Fundus photo taken with a portable handheld camera. 60-degree field of view. Image size 2212x1659: 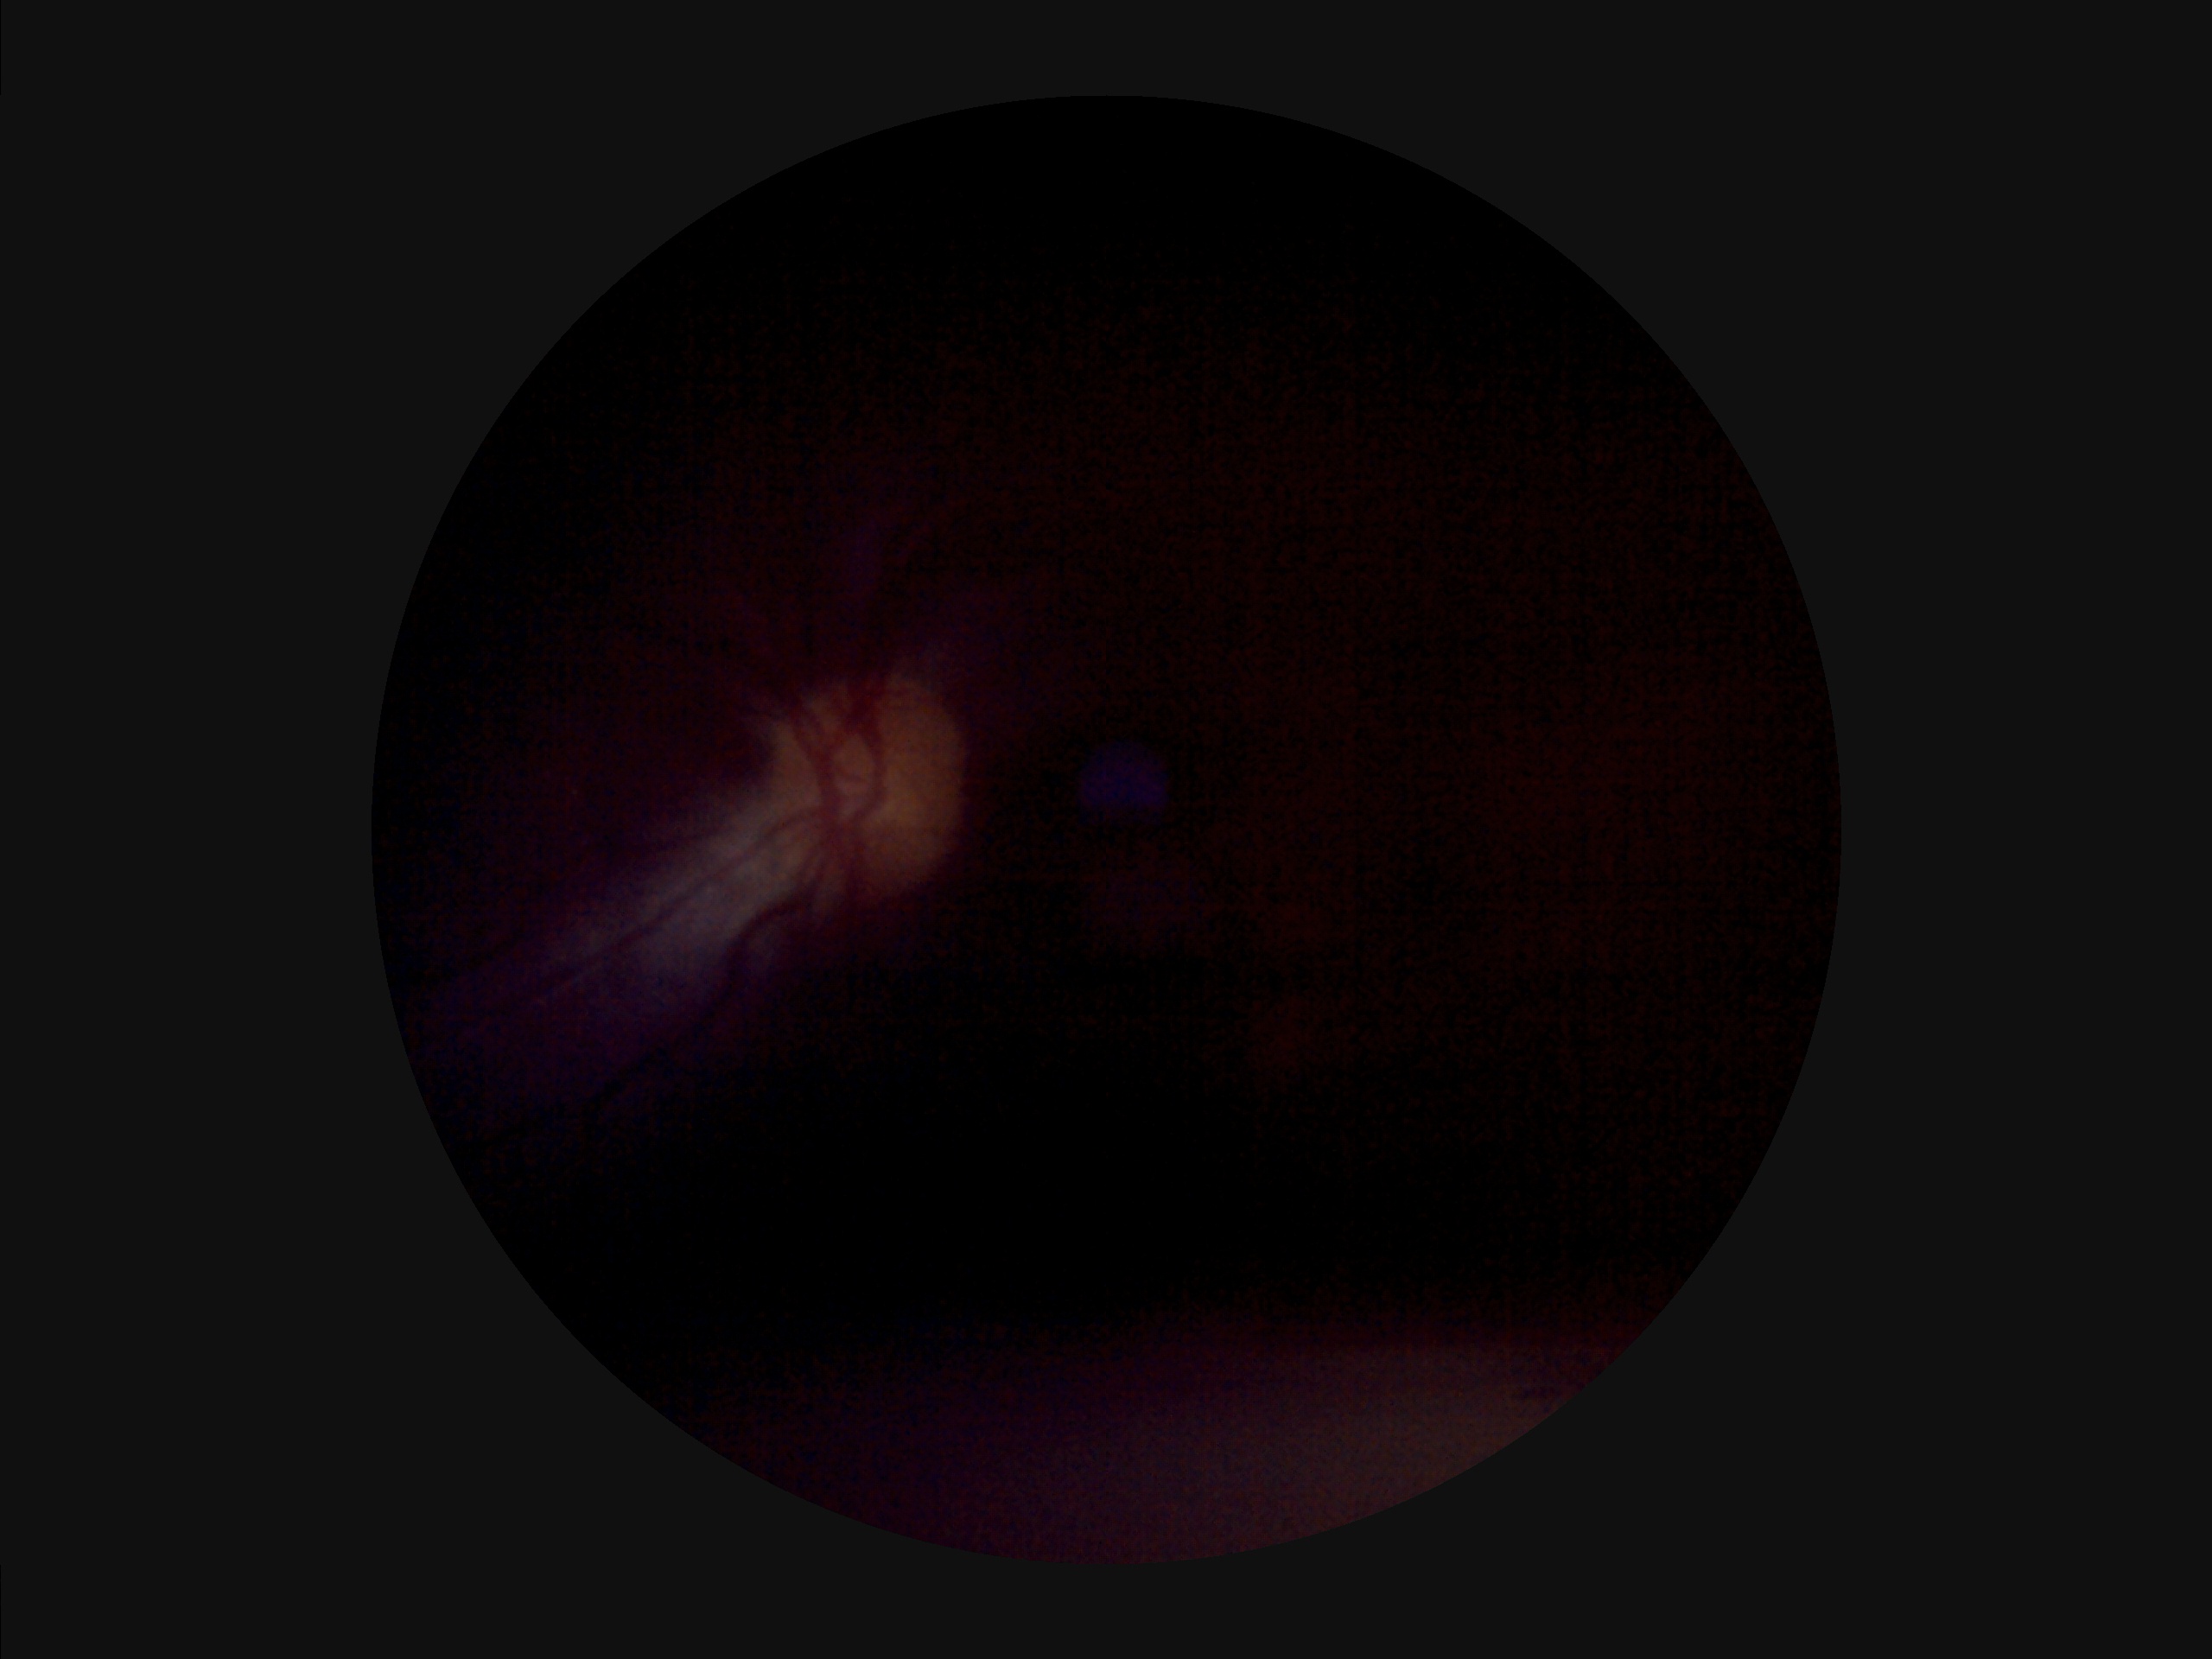

{"contrast": "narrow intensity range, structures hard to distinguish", "overall_quality": "inadequate for clinical interpretation", "clarity": "out of focus, structures indistinct", "illumination": "uneven illumination or color cast"}